496 by 474 pixels. Fundus photo: 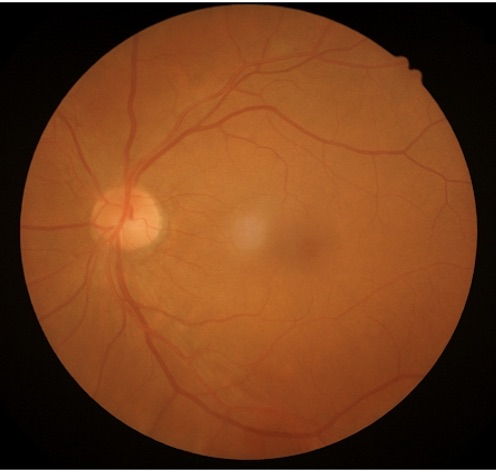
Illumination/color = good illumination and color balance
Clarity = sharp throughout the field
Contrast = vessels and details readily distinguishable